Color fundus image
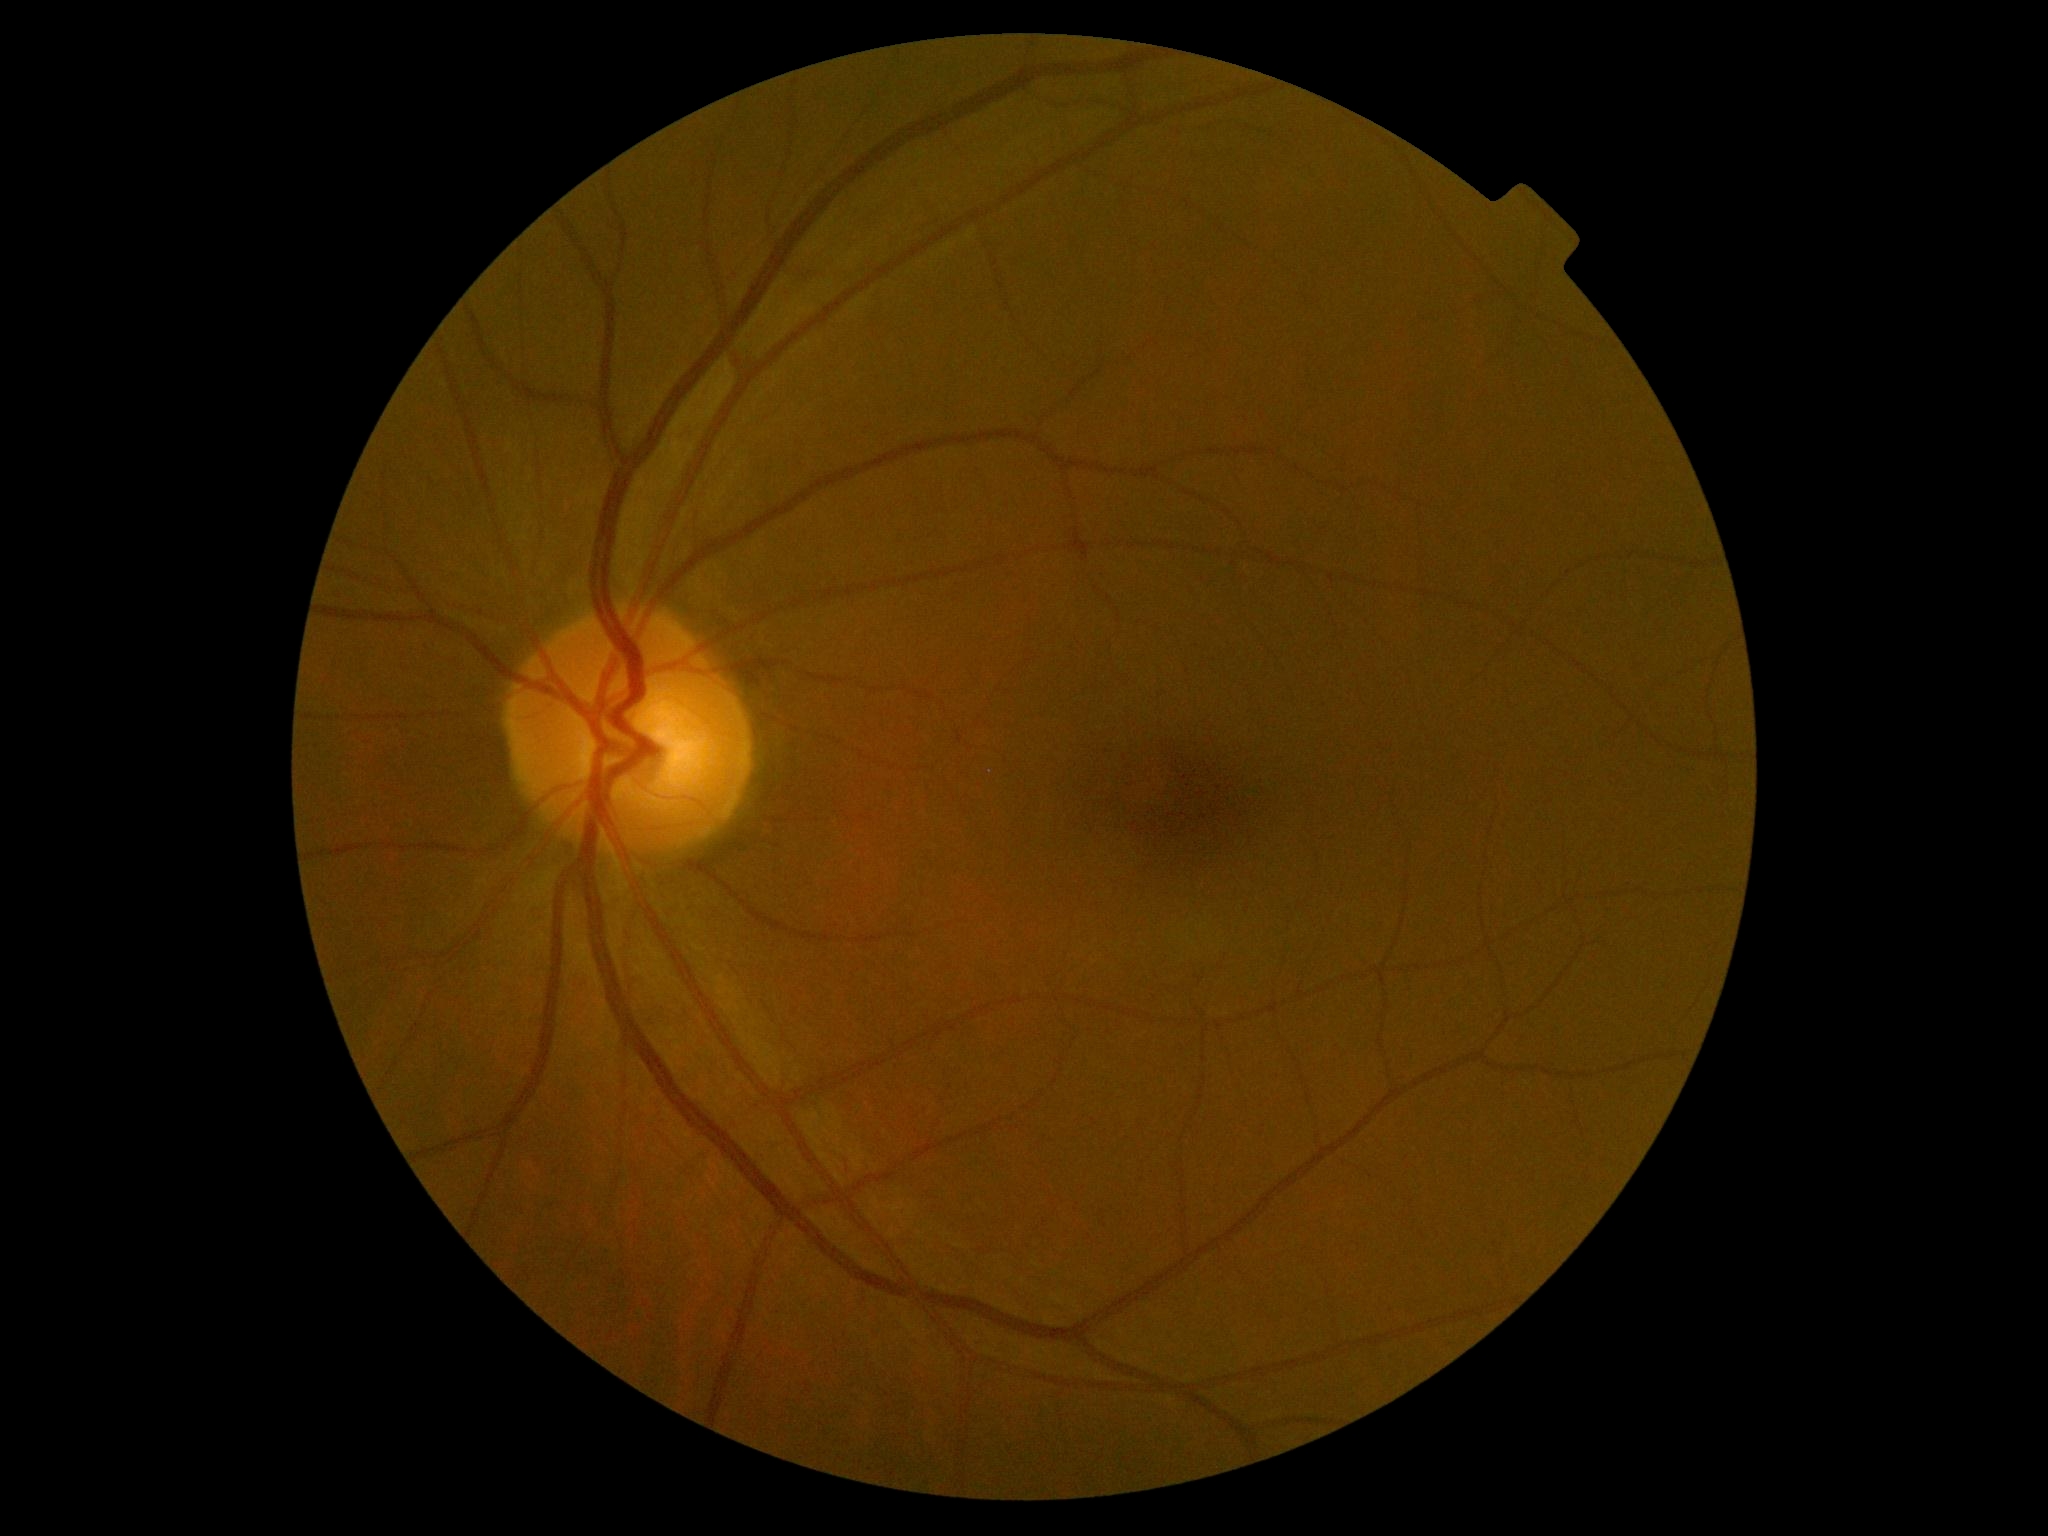 dr_grade: grade 0 (no apparent retinopathy)